45° field of view; retinal fundus photograph; nonmydriatic; camera: NIDEK AFC-230; 848 by 848 pixels — 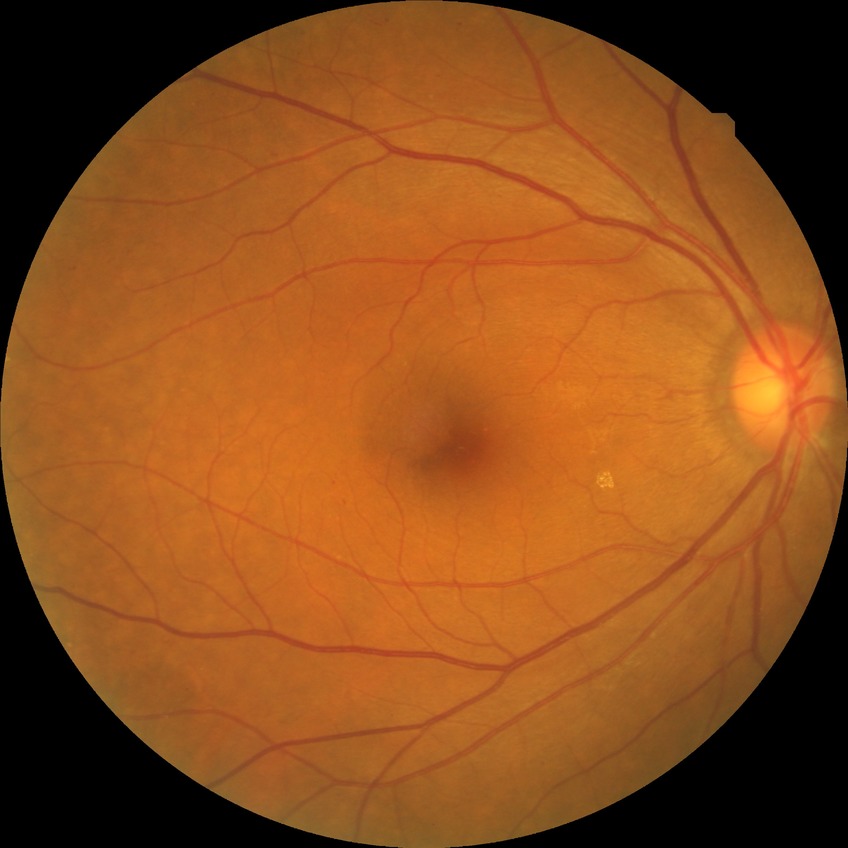
Diabetic retinopathy (DR) is SDR (simple diabetic retinopathy).